848x848.
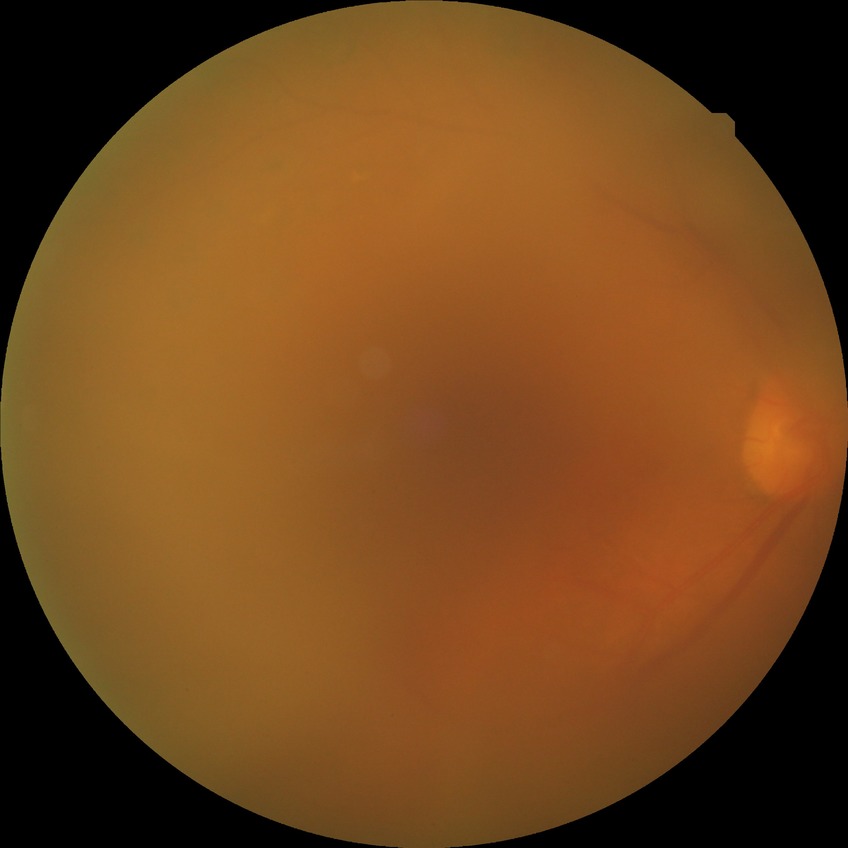
diabetic retinopathy (DR): PDR (proliferative diabetic retinopathy).